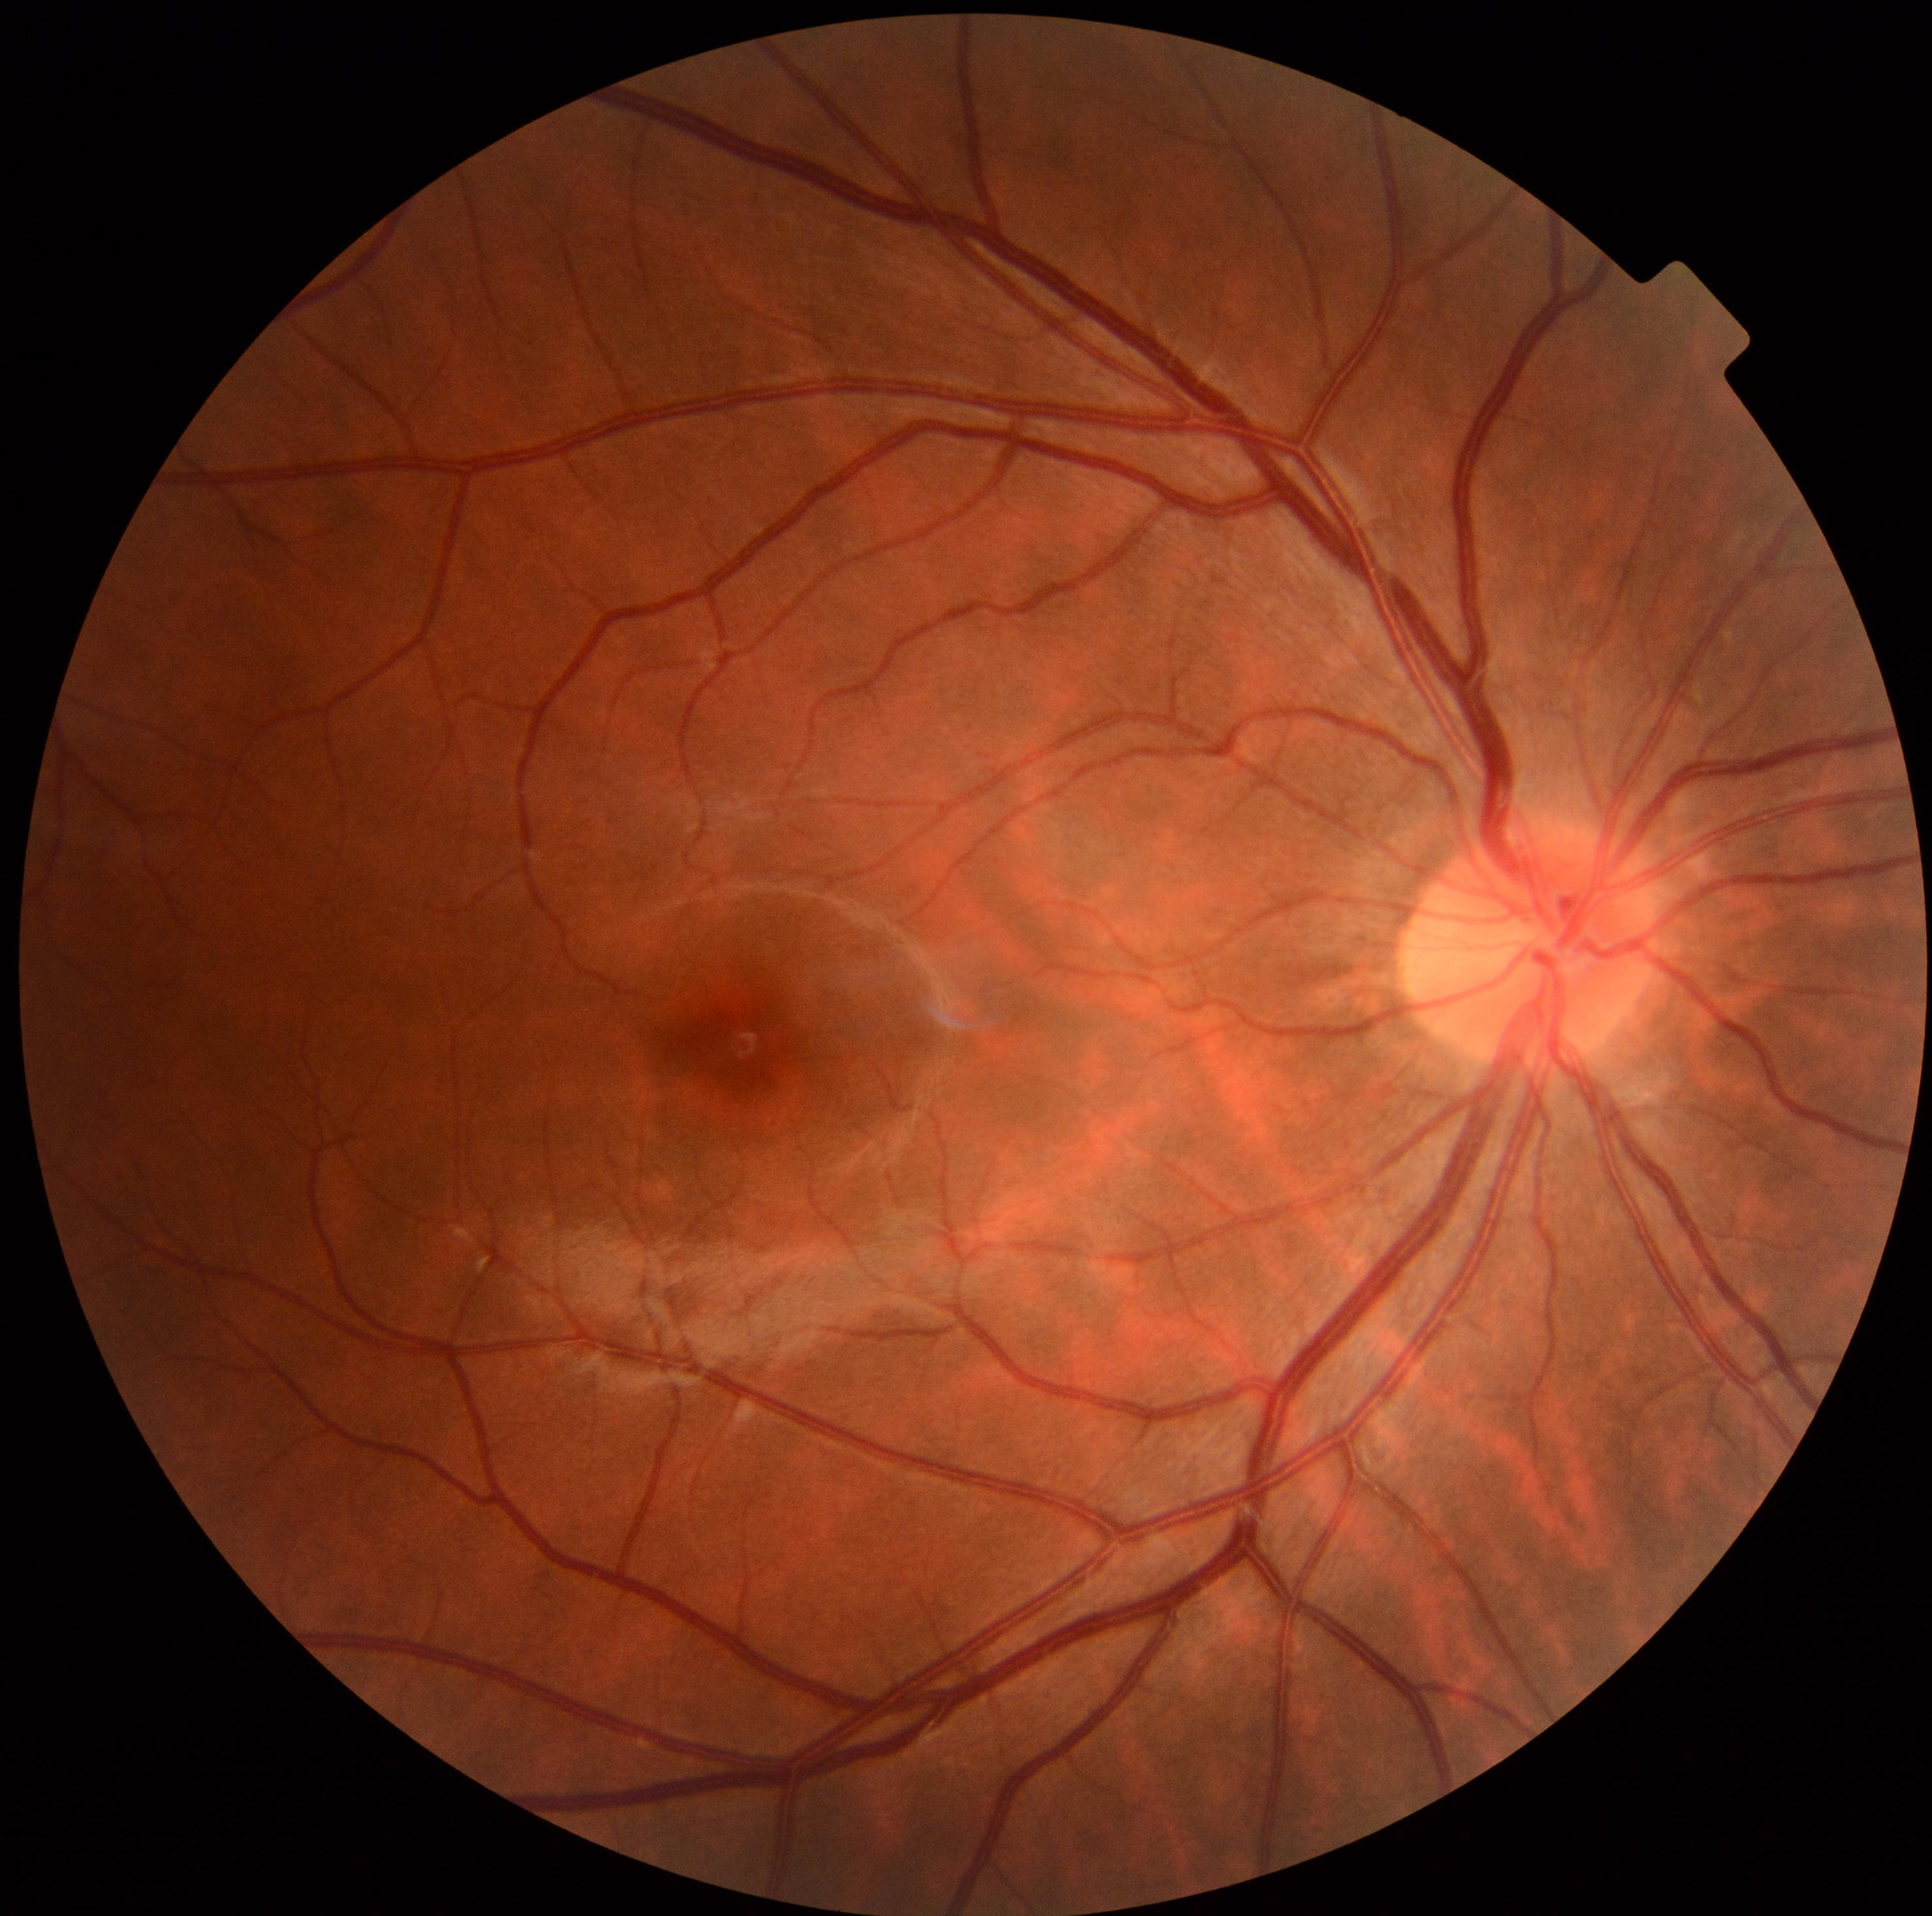

{"dr_grade": "0/4 — no visible signs of diabetic retinopathy"}